2352x1568px:
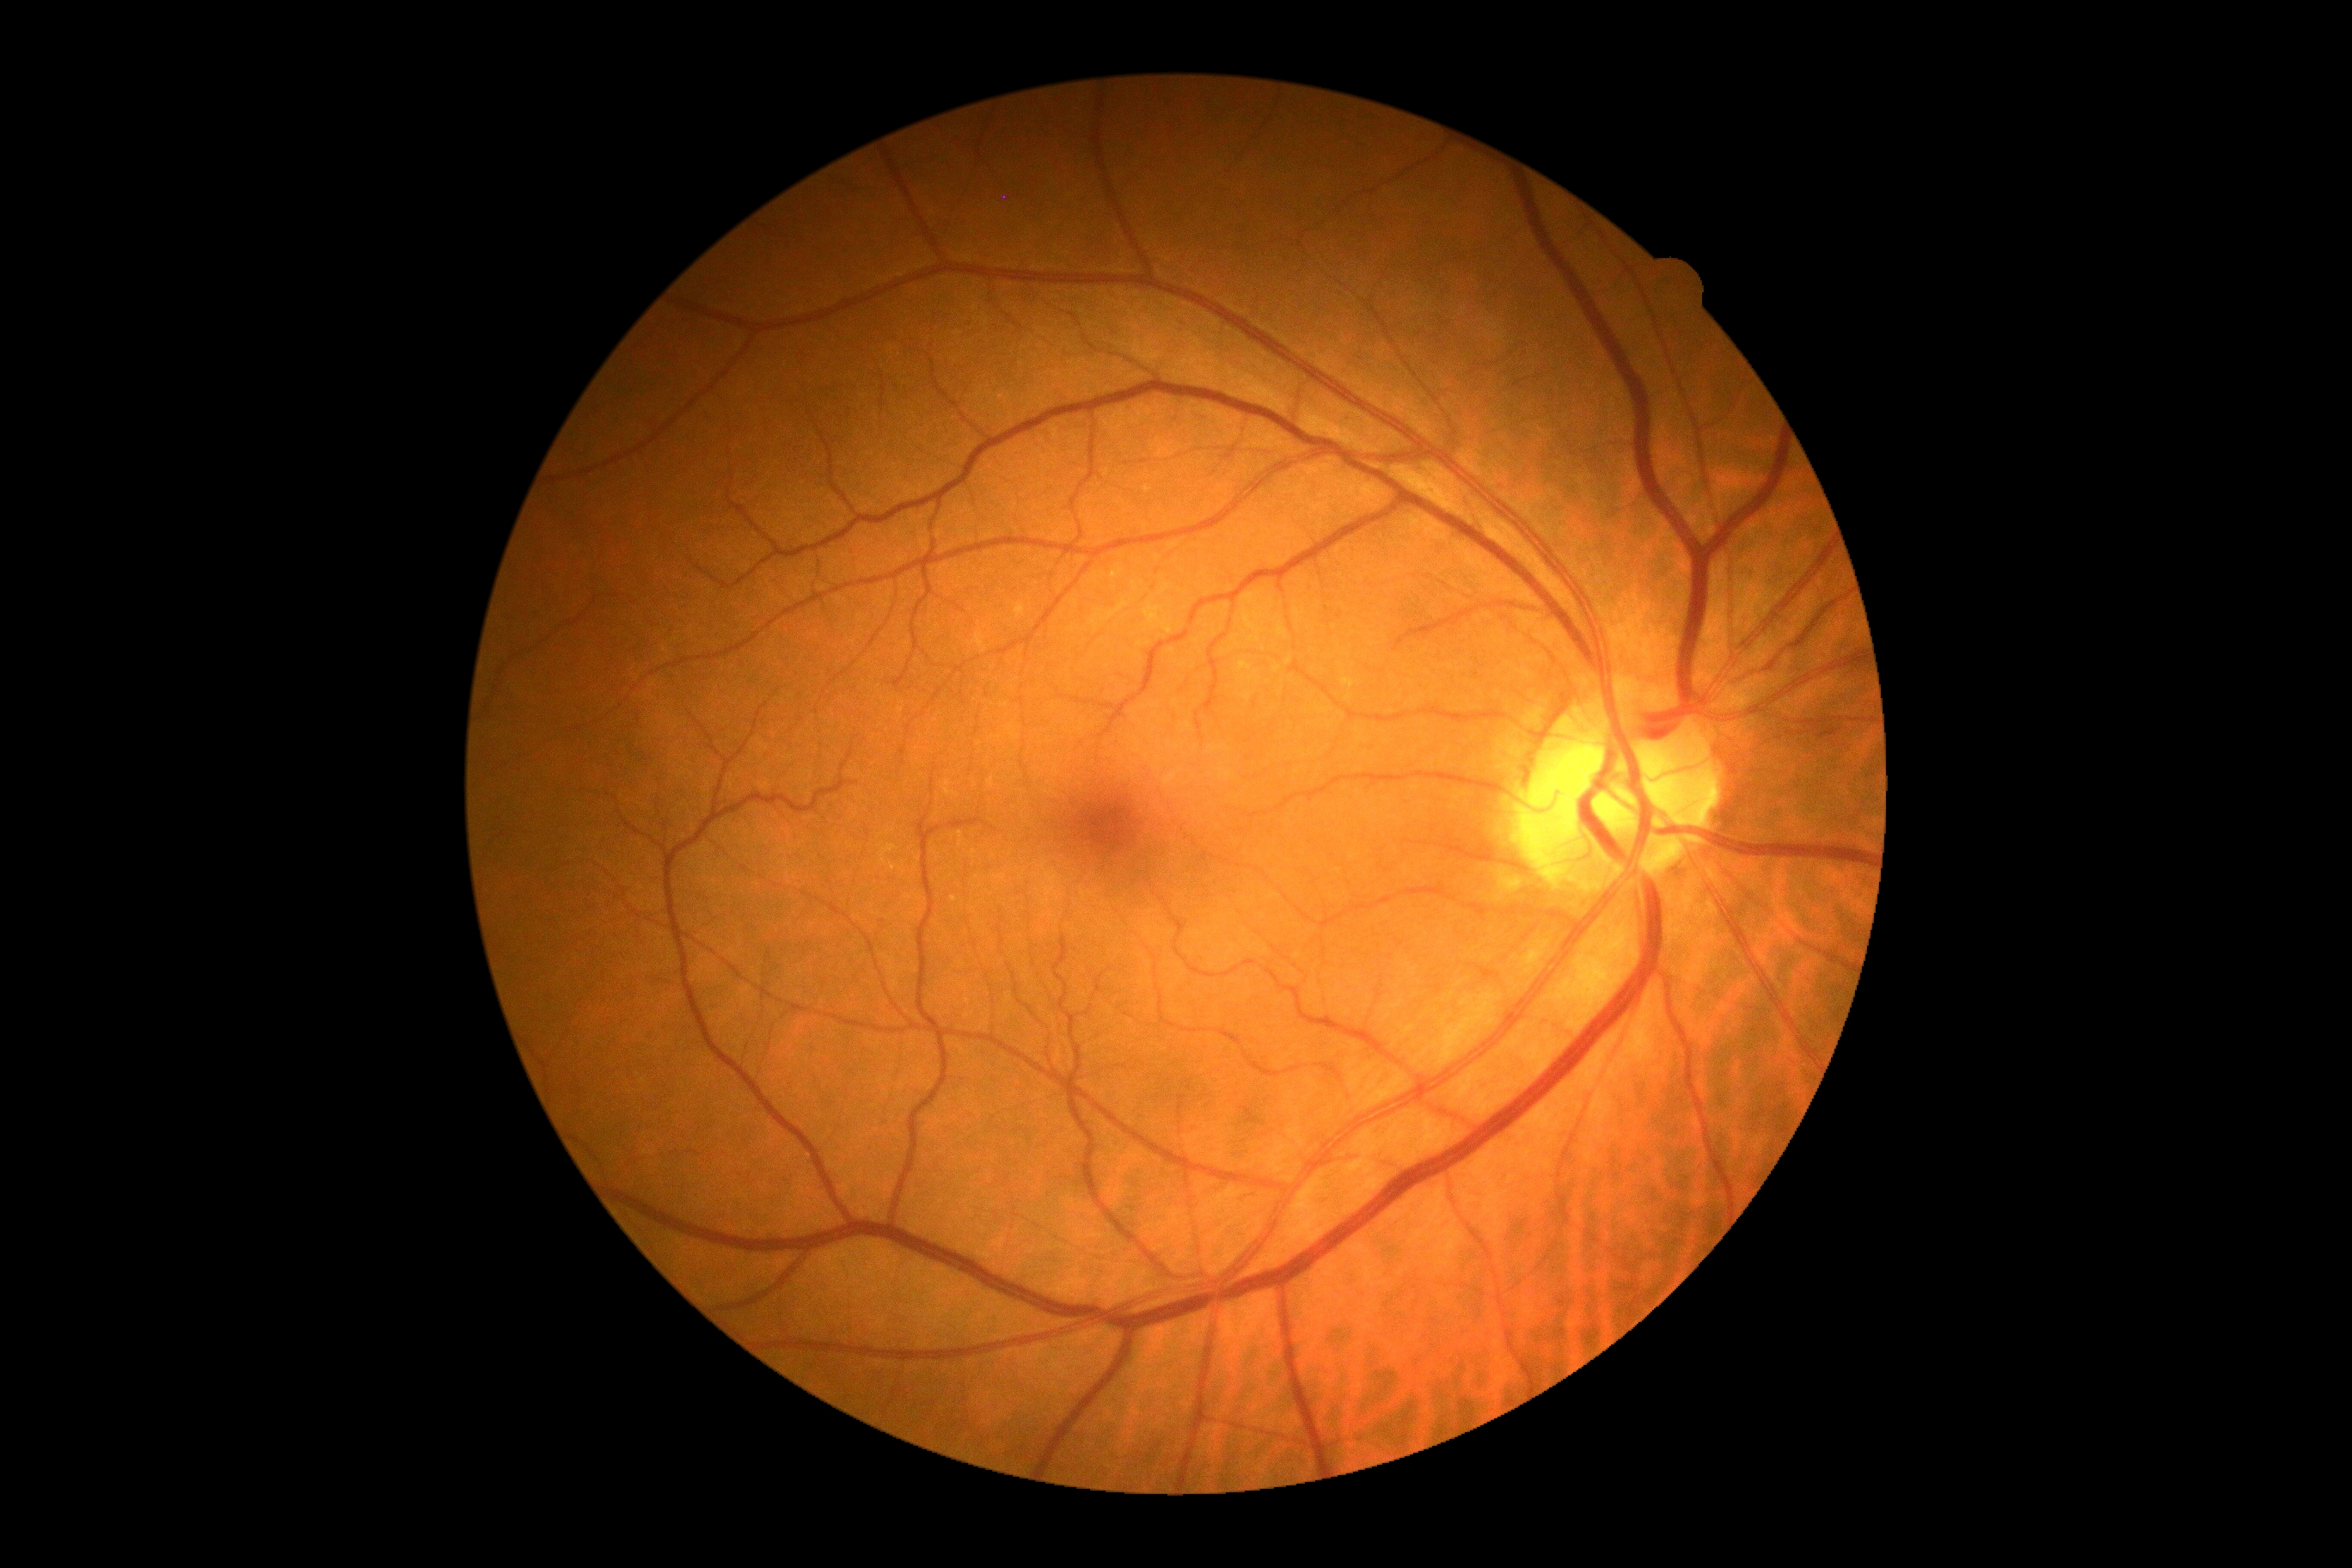
retinopathy@grade 0; DR impression@no apparent DR.